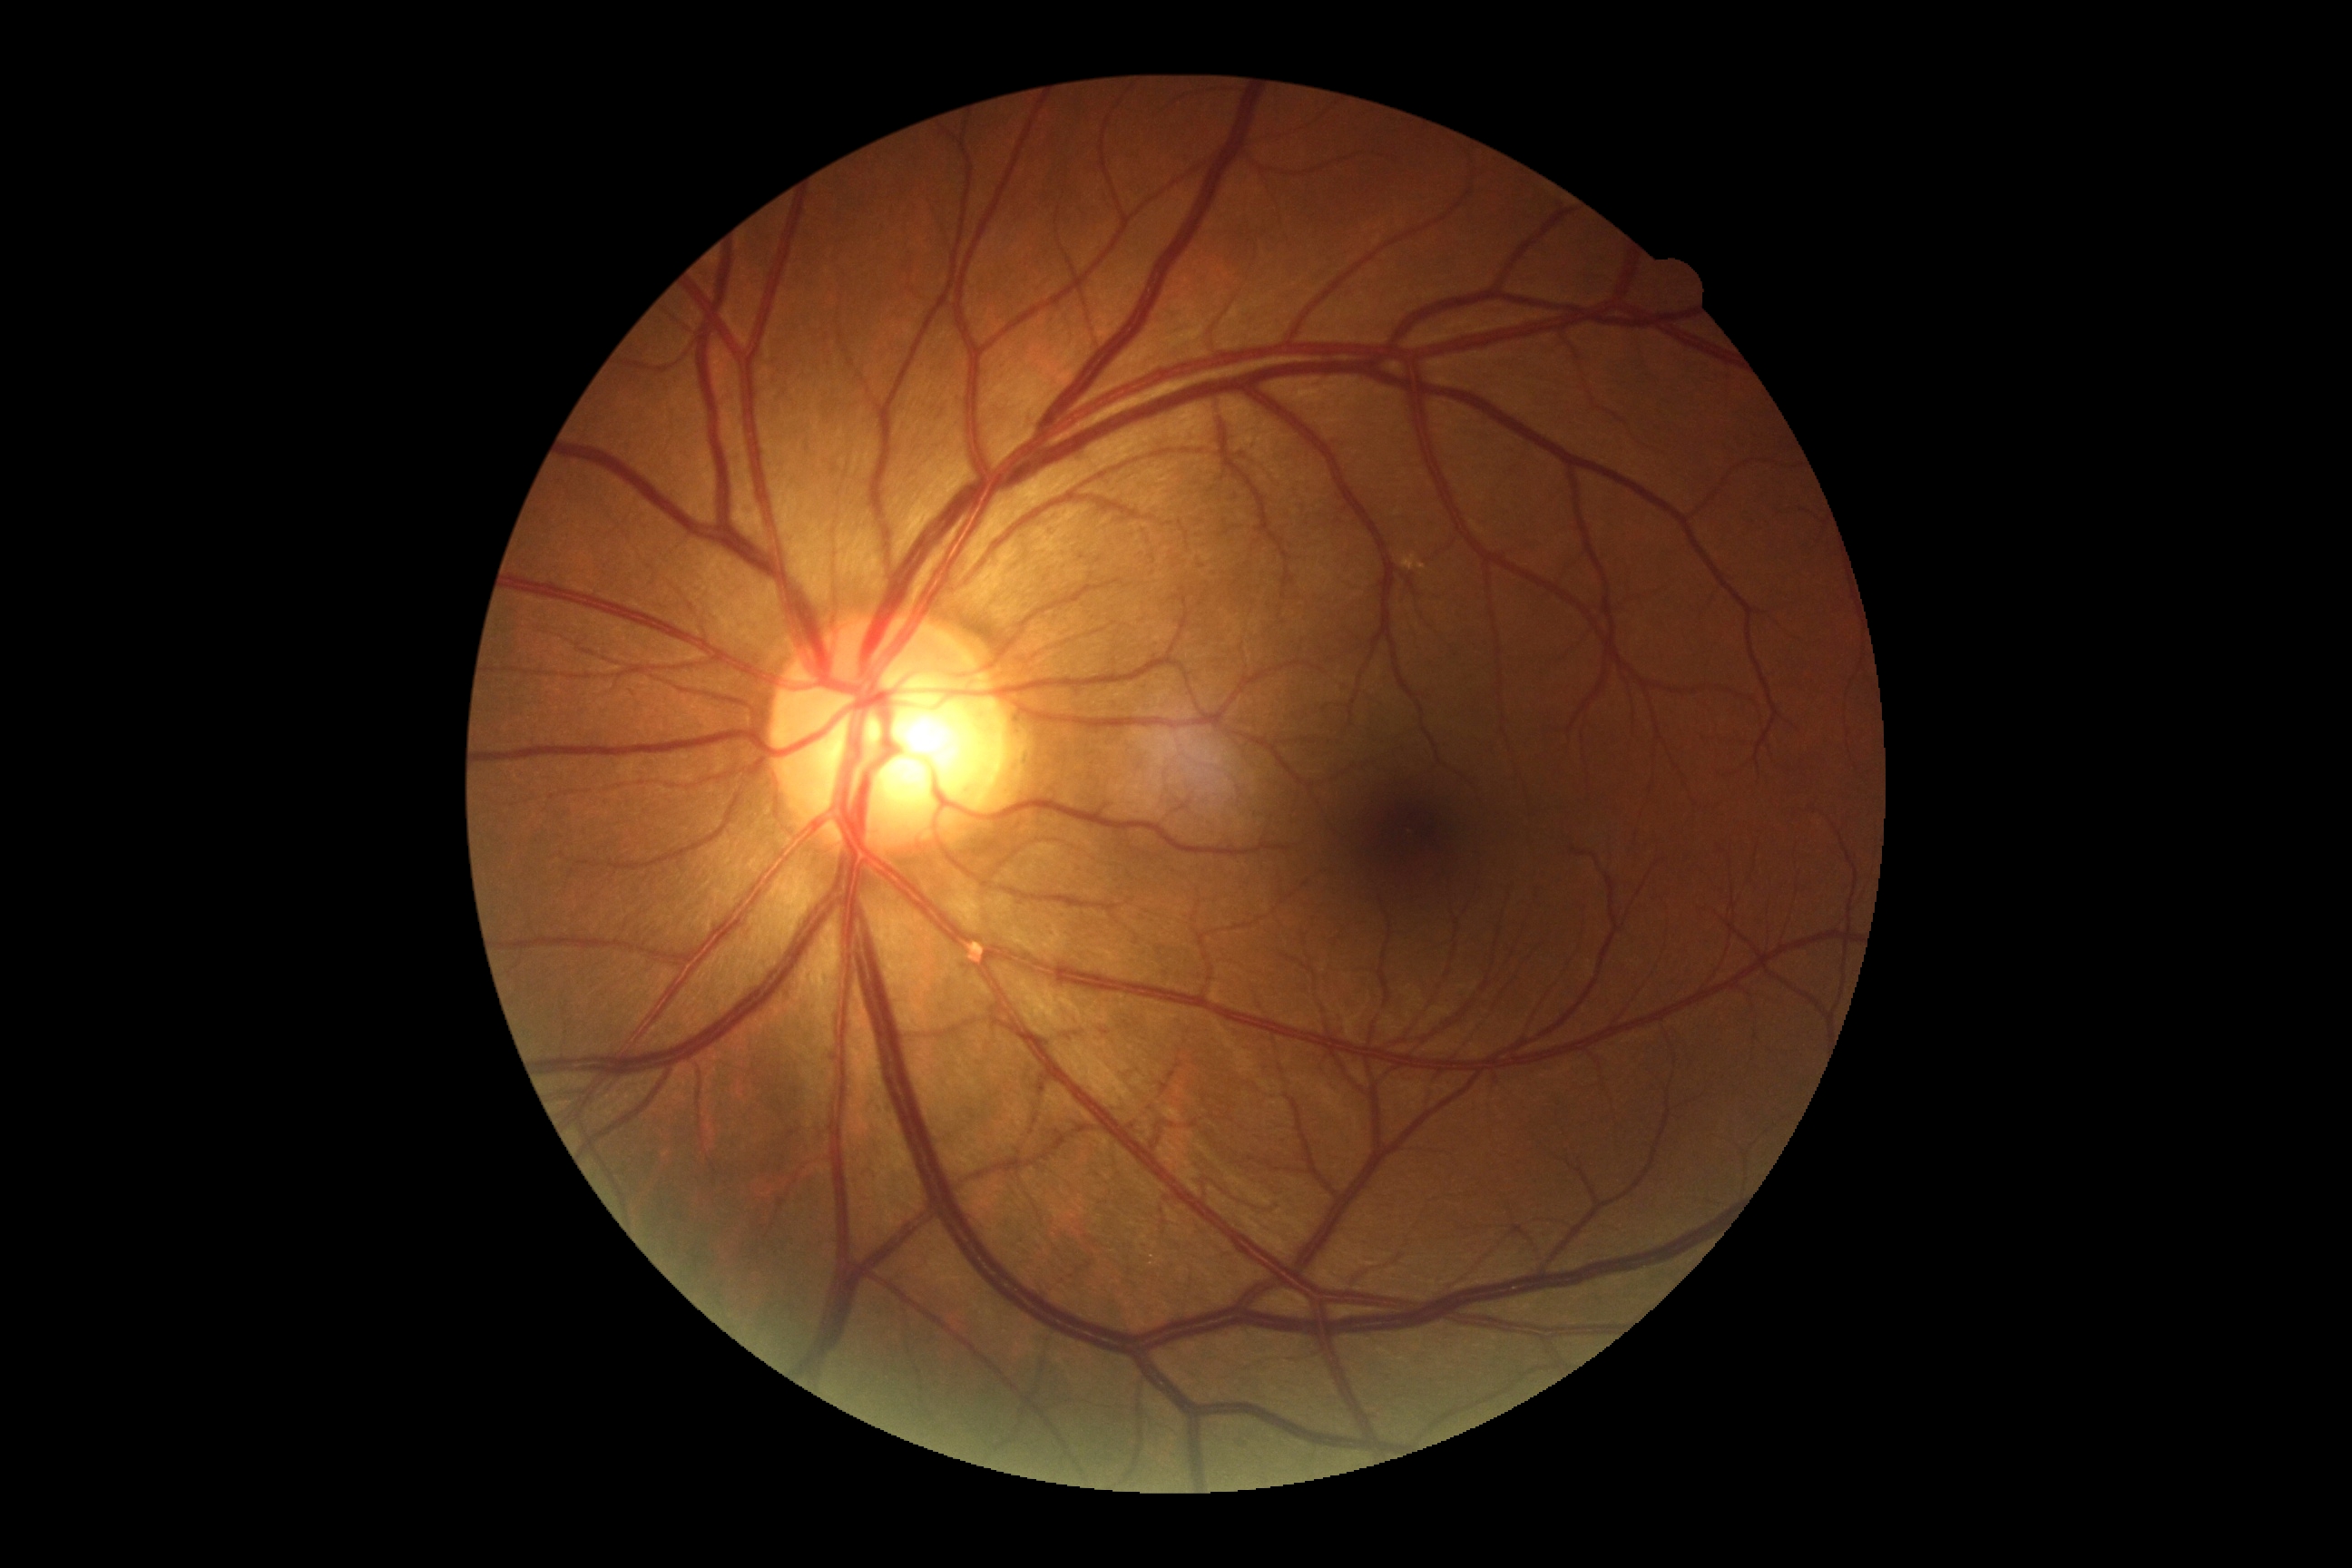
No signs of diabetic retinopathy.
DR is no apparent diabetic retinopathy (grade 0) — no visible signs of diabetic retinopathy.